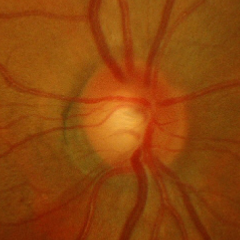
Demonstrates no glaucomatous optic neuropathy.